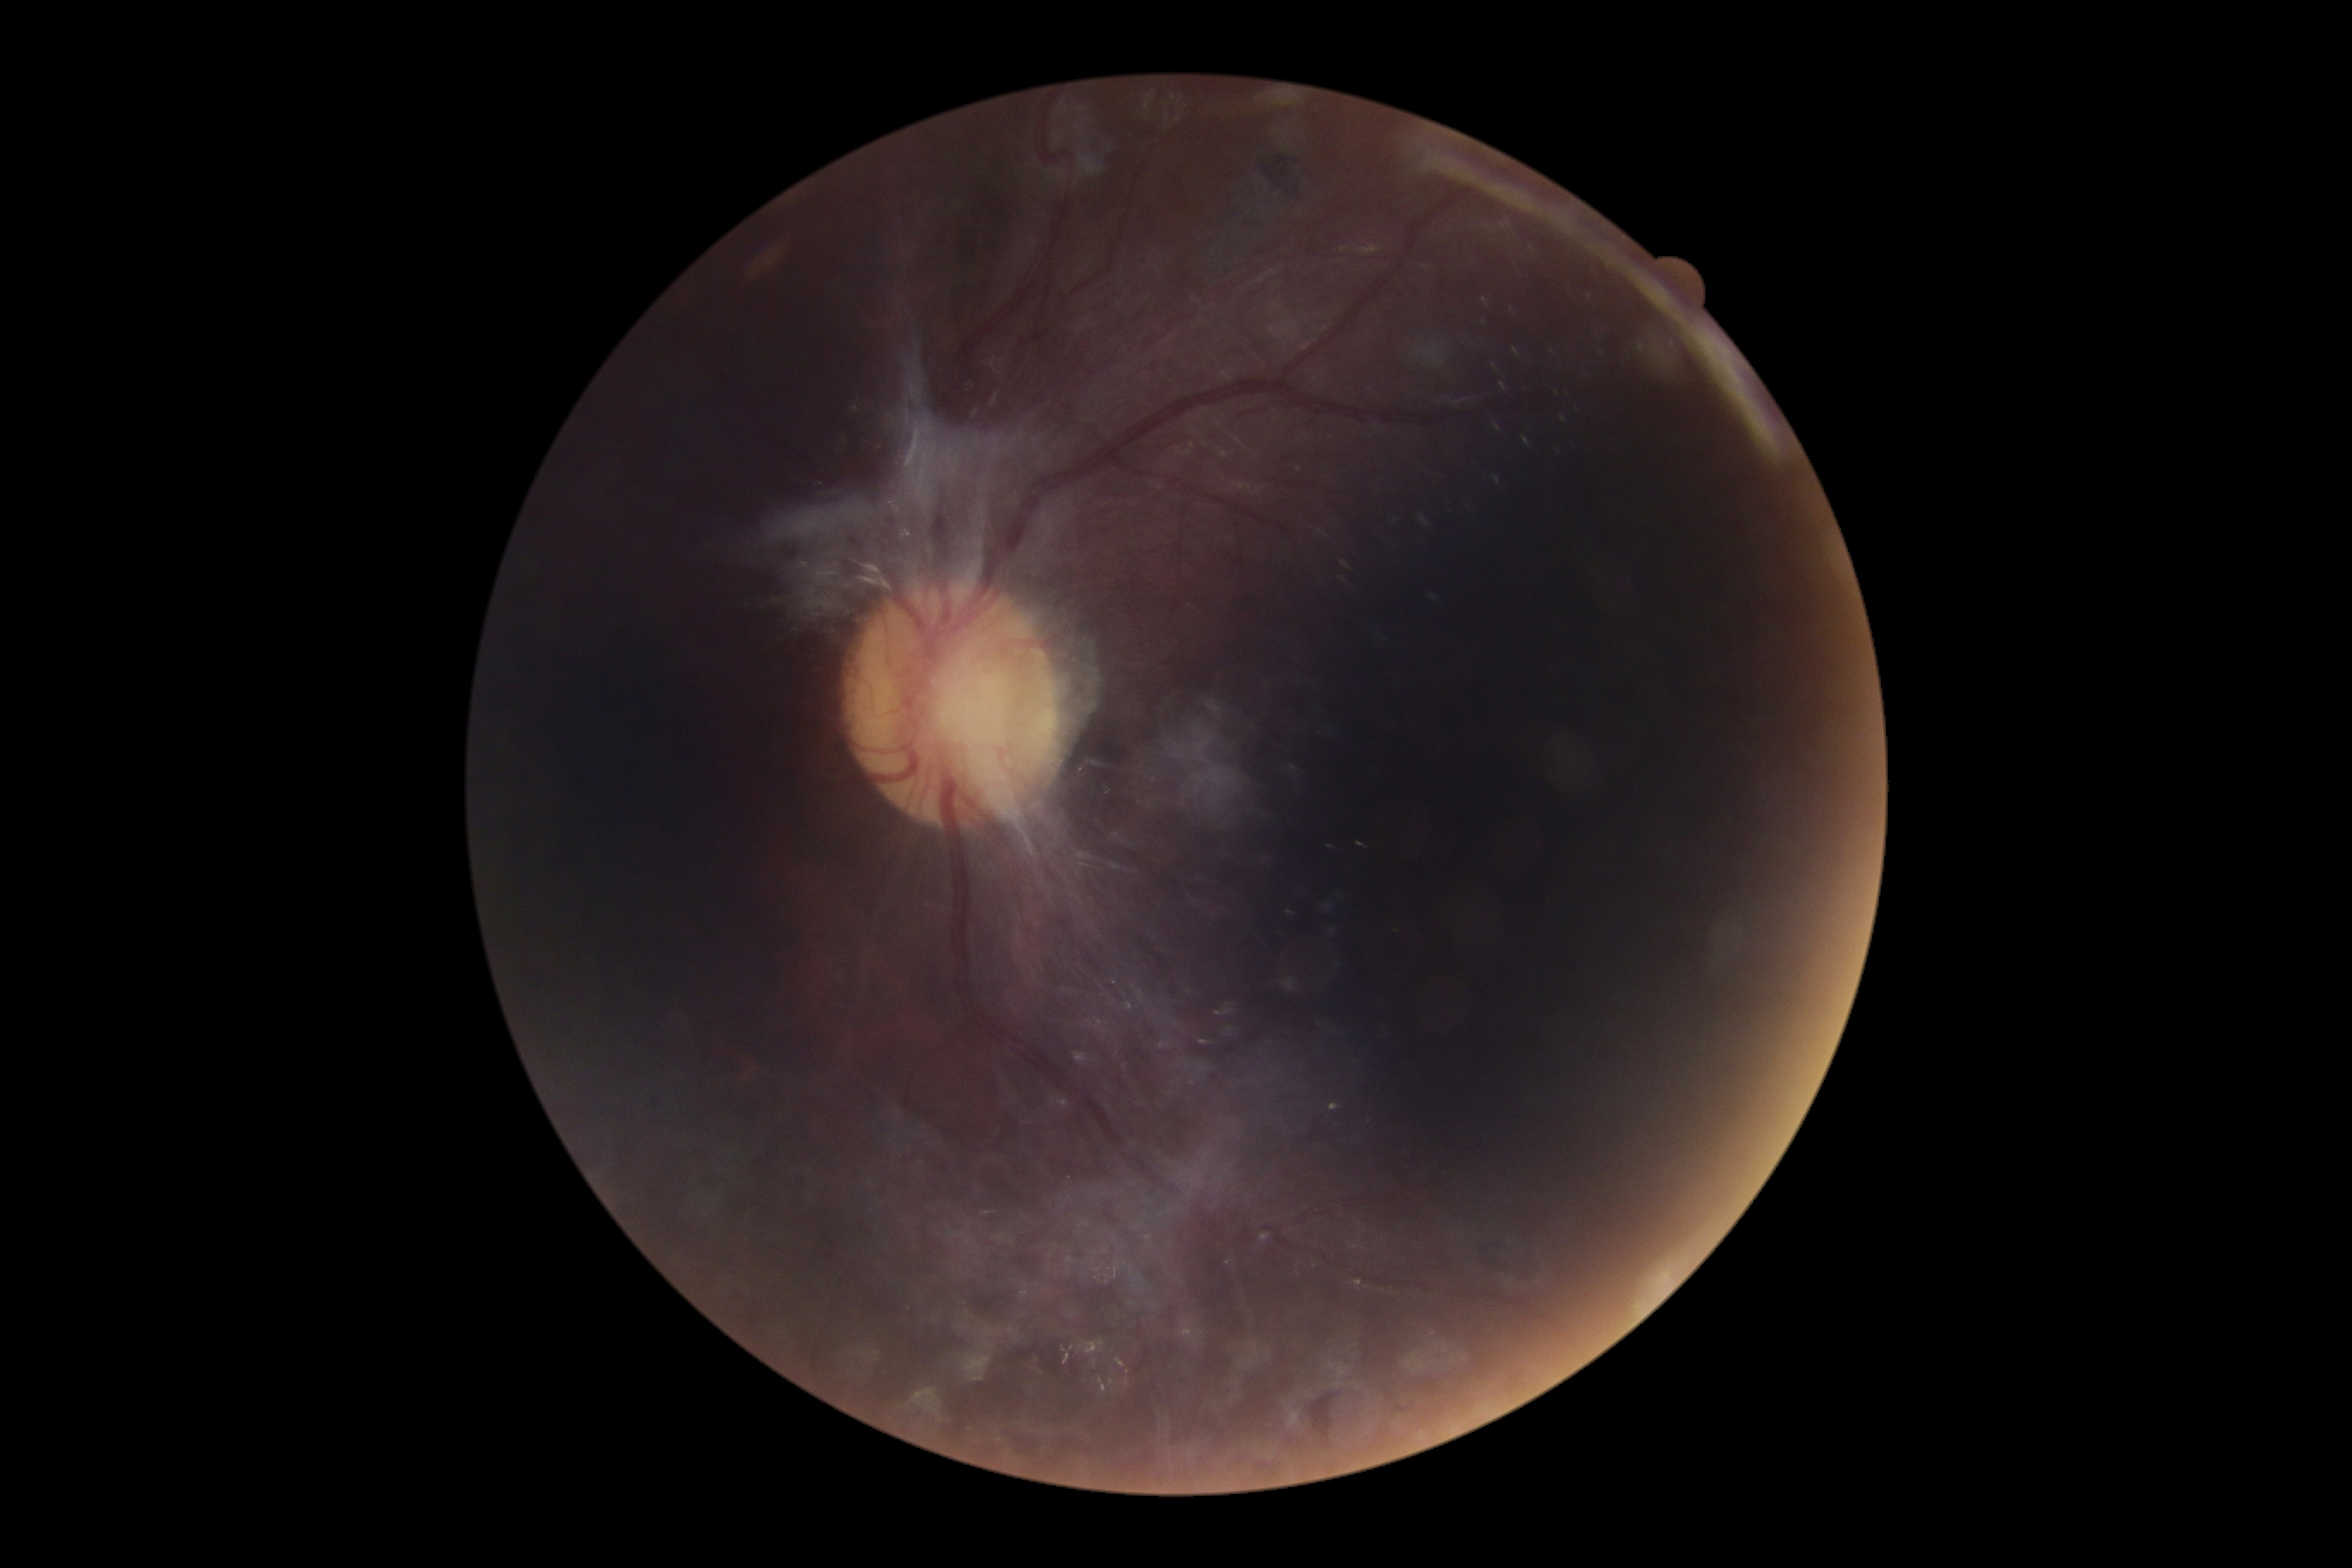 Diabetic retinopathy grade: 4 (PDR).